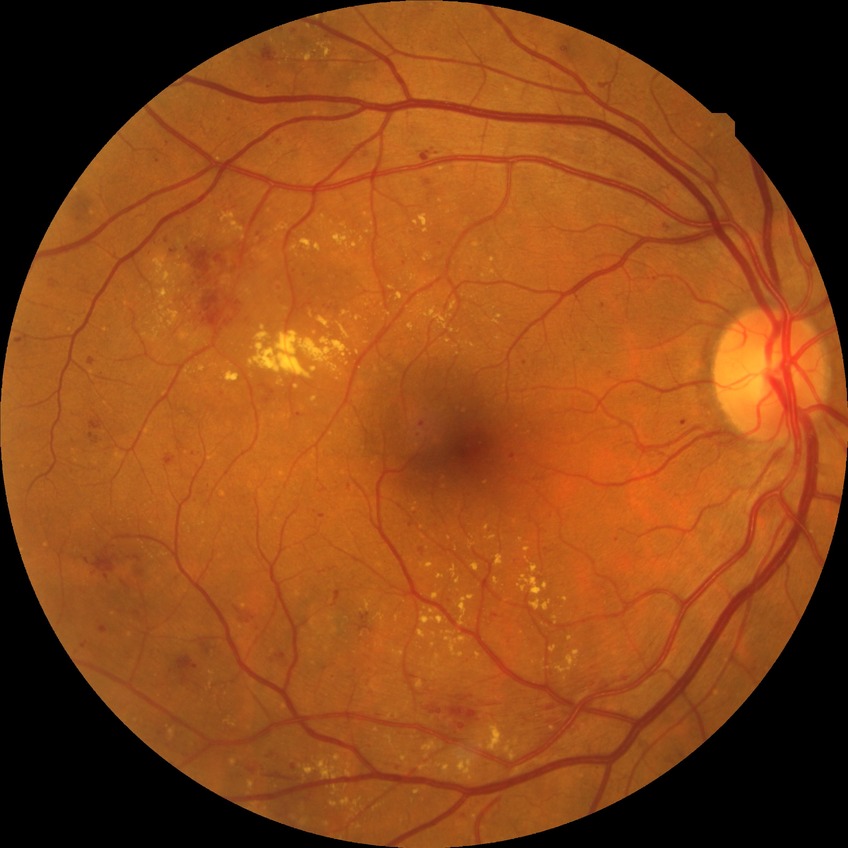
Findings:
- Davis grade — PPDR
- DR class — non-proliferative diabetic retinopathy